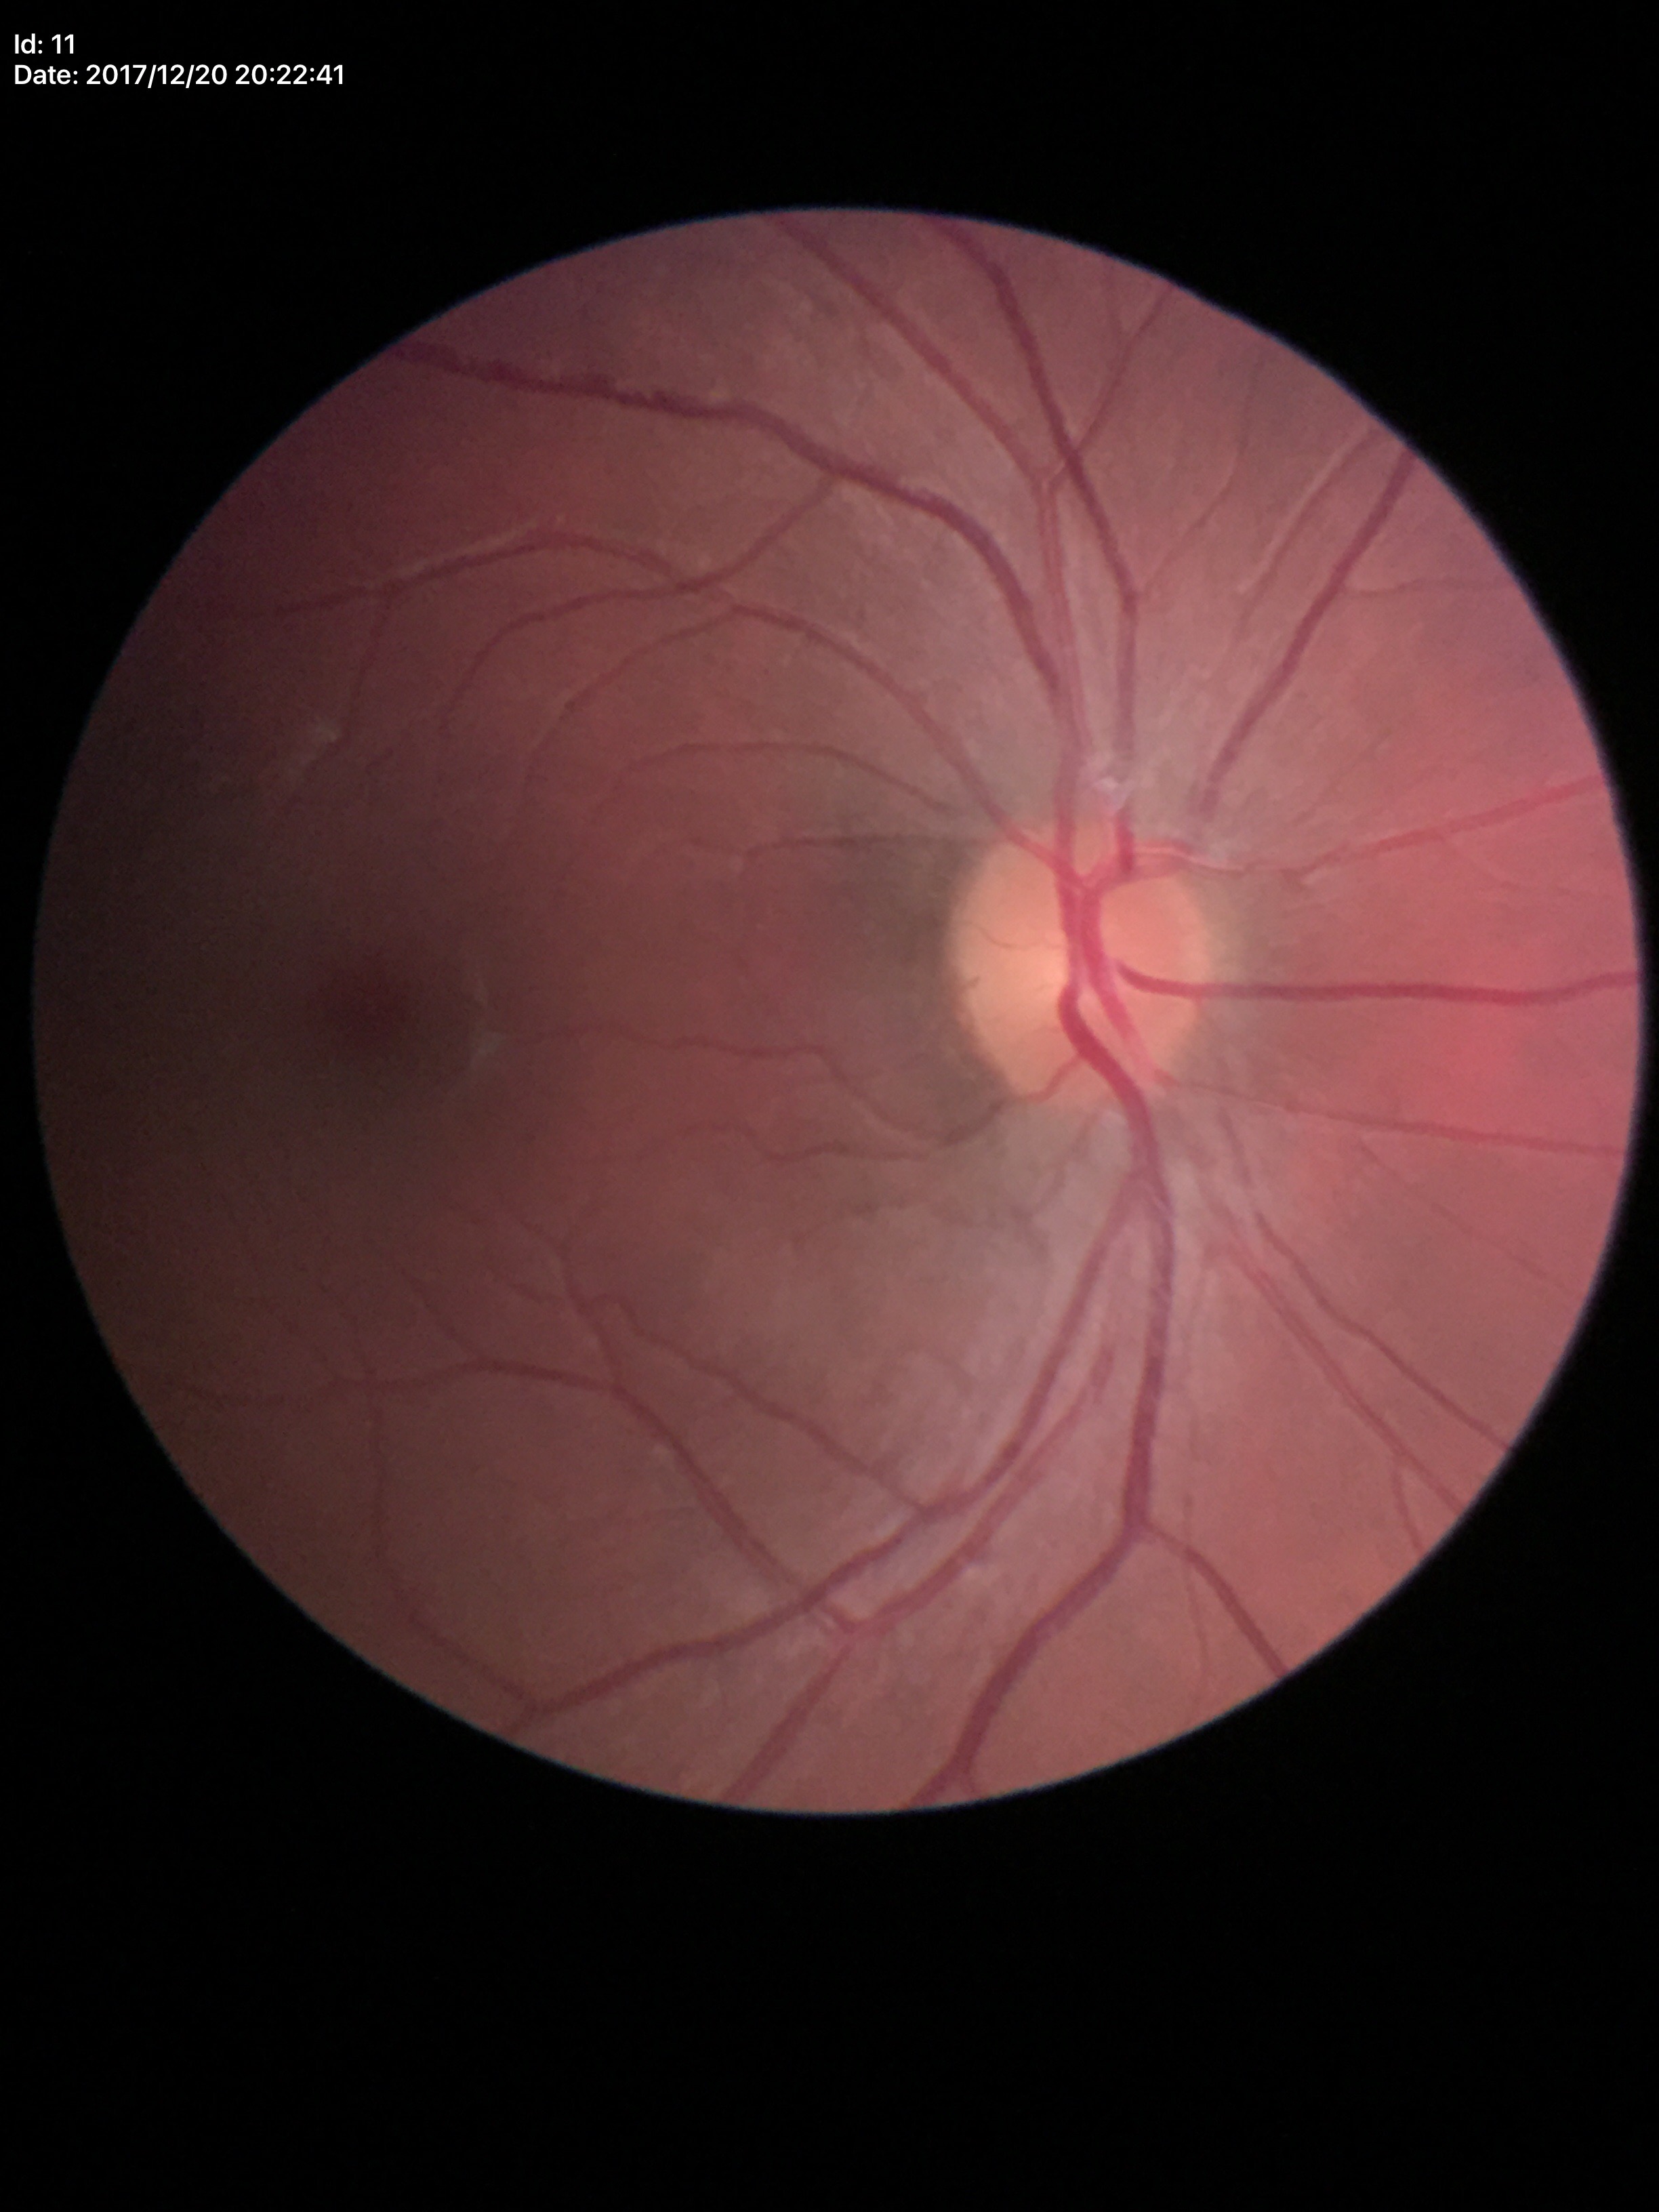

No signs of glaucoma. Horizontal CDR of 0.40. Vertical CDR is 0.40.